Image size 2352x1568. Color fundus image.
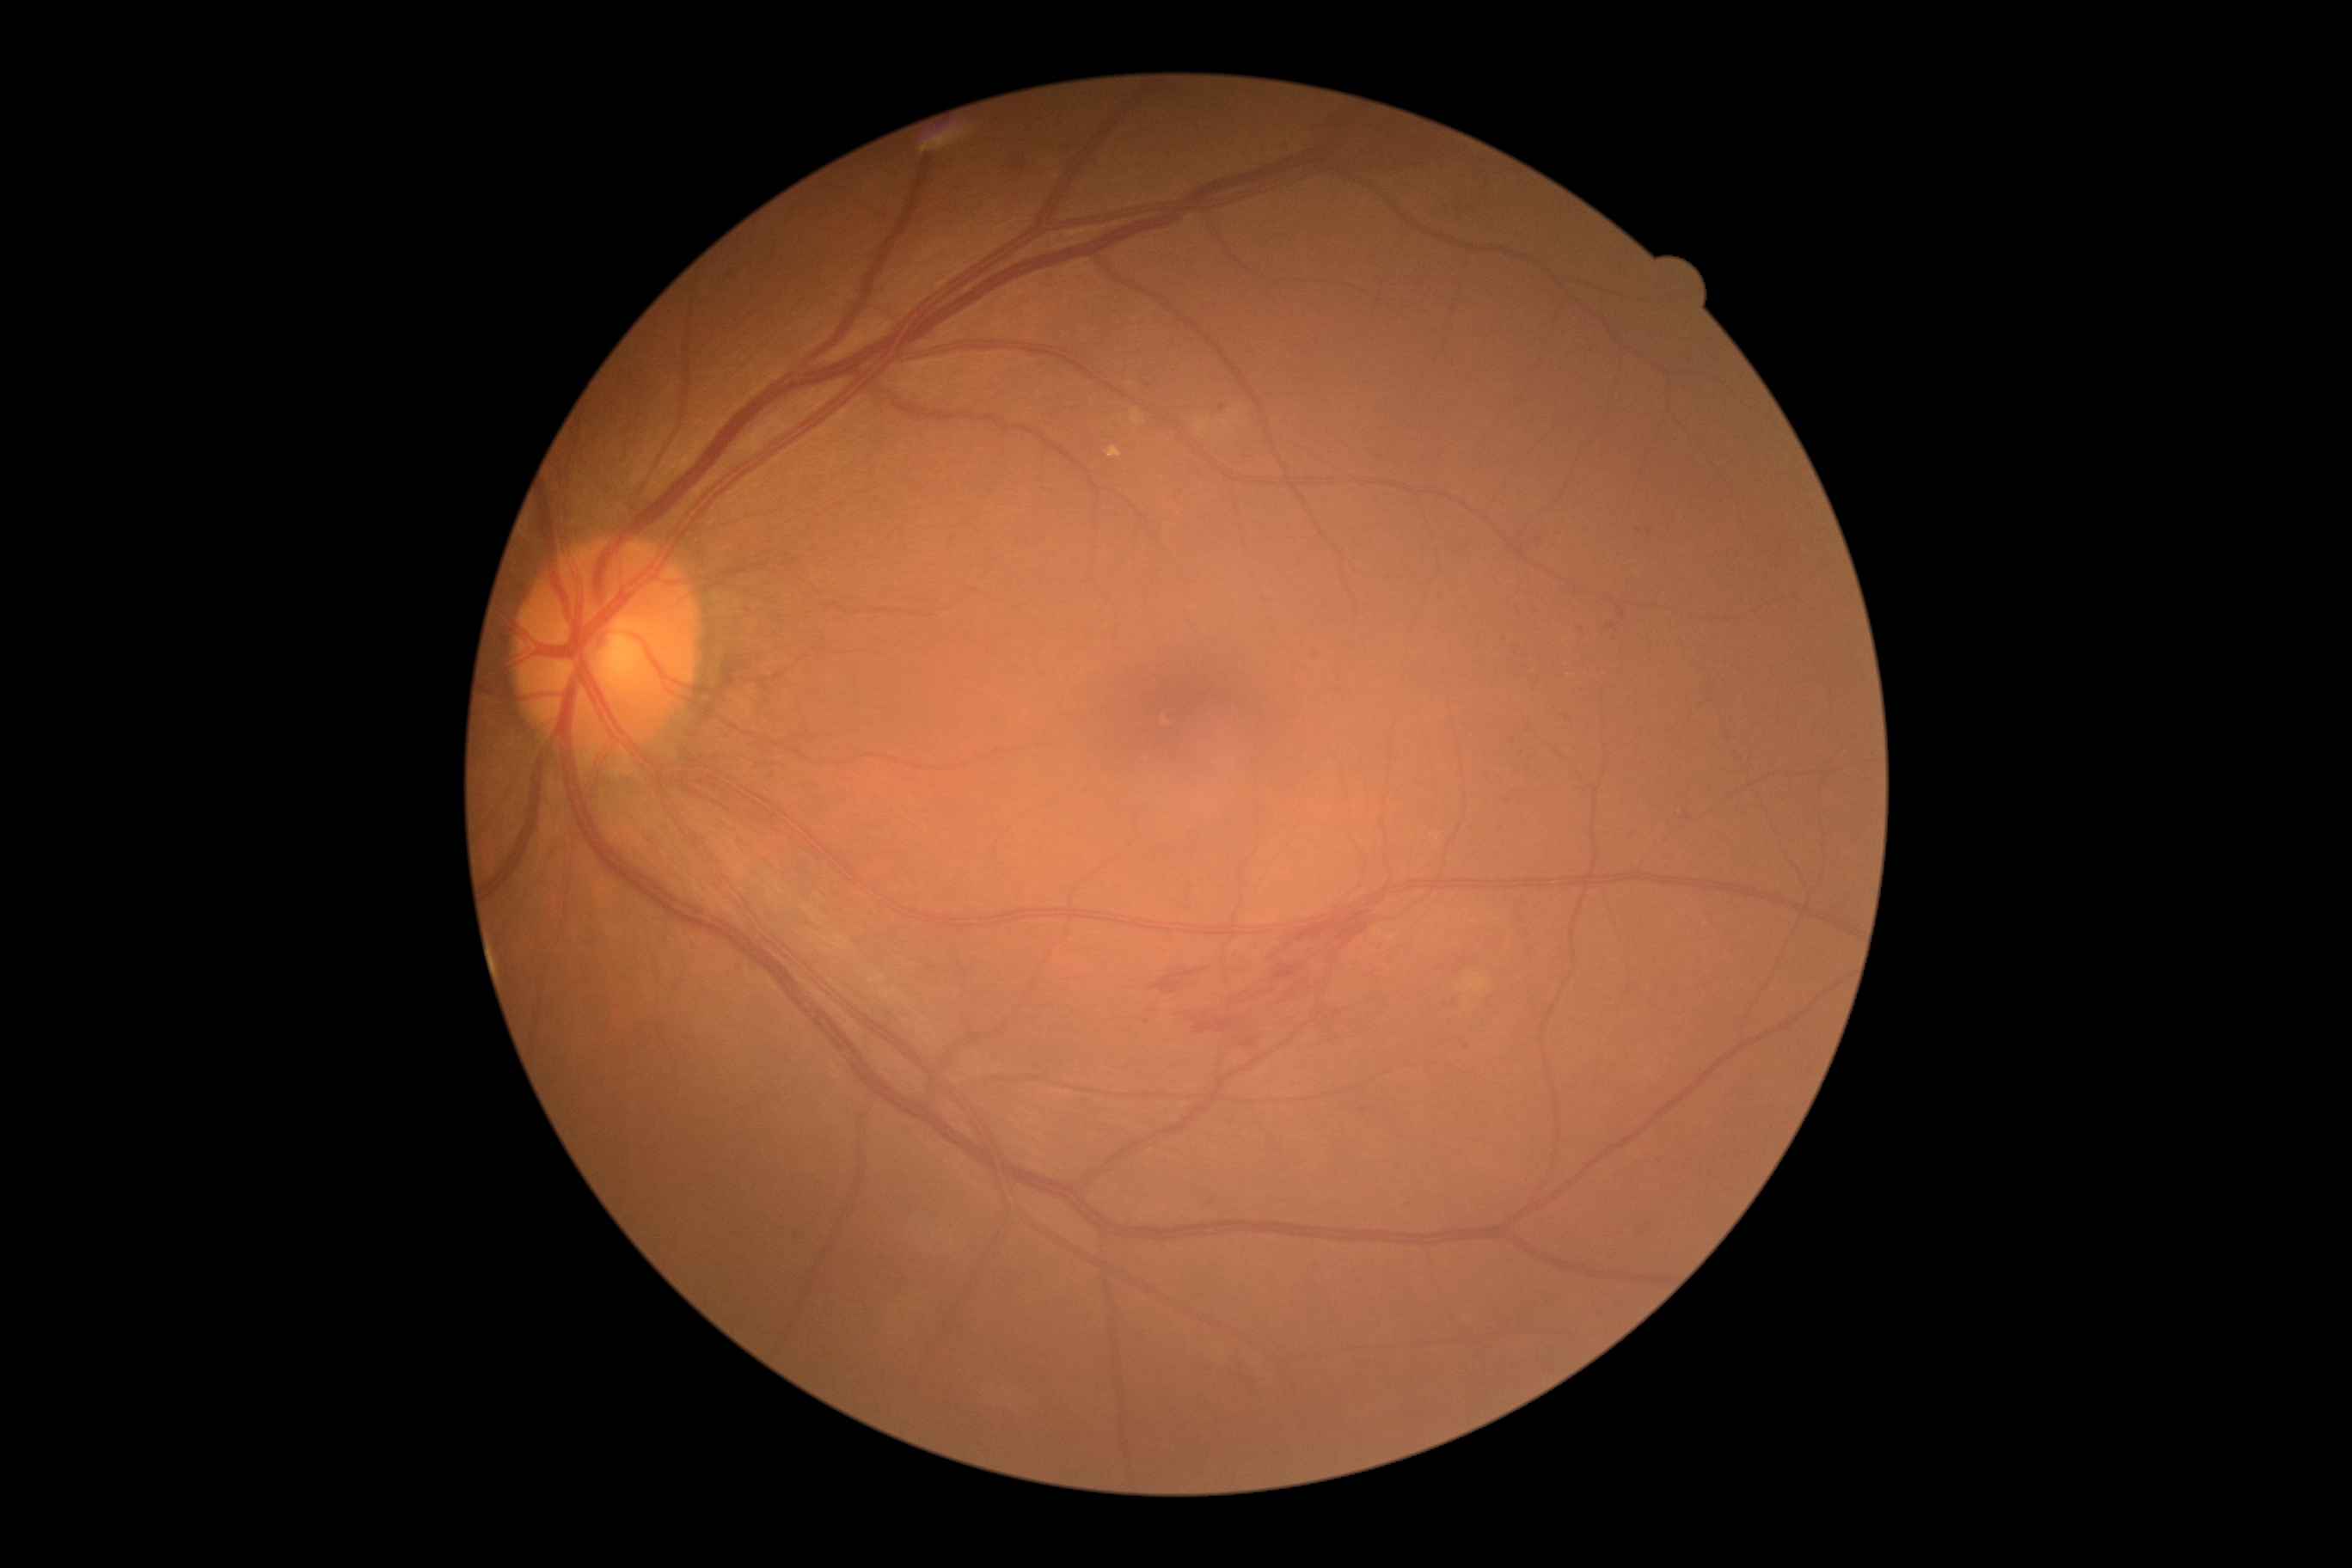

DR grade: 2 (moderate NPDR)
Selected lesions:
MAs (partial): region(1682, 814, 1691, 821), region(1204, 1201, 1215, 1213), region(1409, 1203, 1416, 1211), region(1450, 1000, 1461, 1010), region(1617, 606, 1626, 618), region(1500, 800, 1507, 809), region(1607, 625, 1615, 630)
Smaller MAs around pt(1464, 962), pt(1462, 1041), pt(1568, 718), pt(1581, 630), pt(1639, 532), pt(1513, 741), pt(1466, 1046), pt(1516, 653), pt(1223, 408), pt(1149, 386), pt(1230, 1122), pt(1649, 532), pt(1316, 655)
HEs: region(1292, 912, 1373, 948), region(1012, 150, 1032, 185), region(1225, 955, 1258, 981), region(1240, 1039, 1256, 1048), region(1149, 969, 1203, 996), region(1302, 104, 1440, 175), region(1309, 1003, 1344, 1036), region(1062, 150, 1079, 173), region(1239, 965, 1304, 1007), region(1077, 159, 1101, 185), region(1191, 1014, 1240, 1034)
EXs: none identified
SEs: none identified